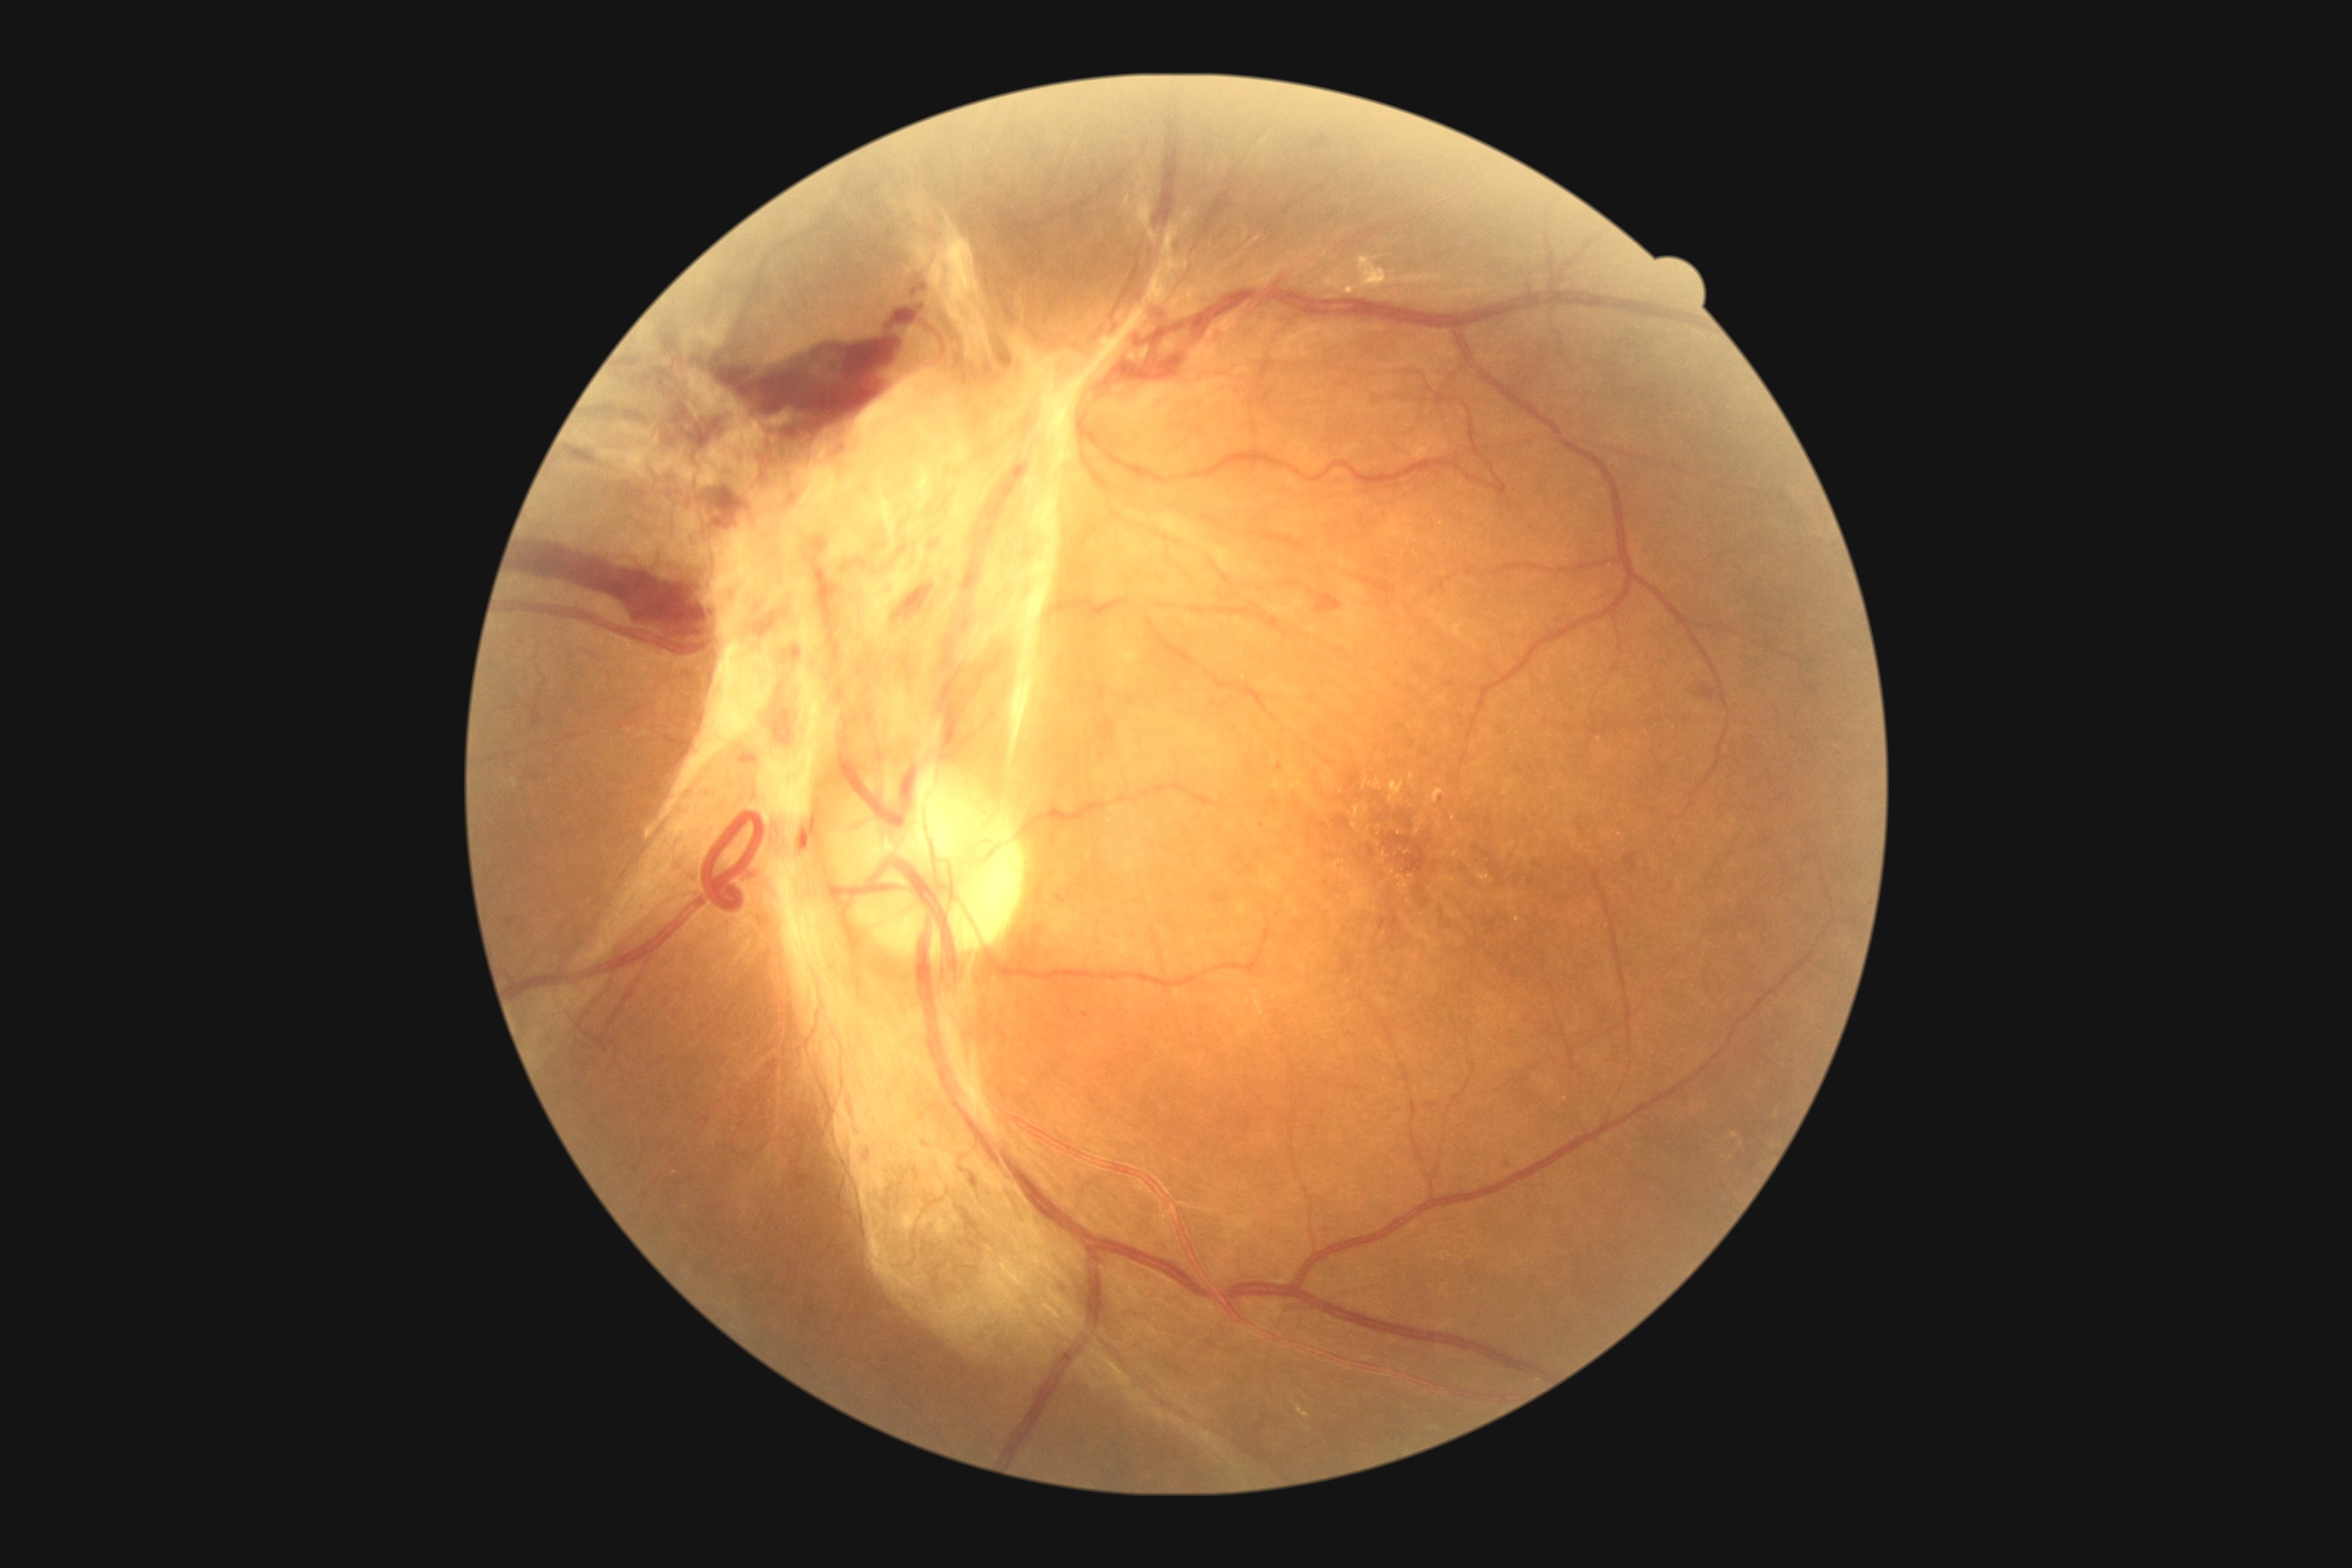
Diabetic retinopathy is 4/4. The retinopathy is classified as proliferative diabetic retinopathy.